Macula-centered field.
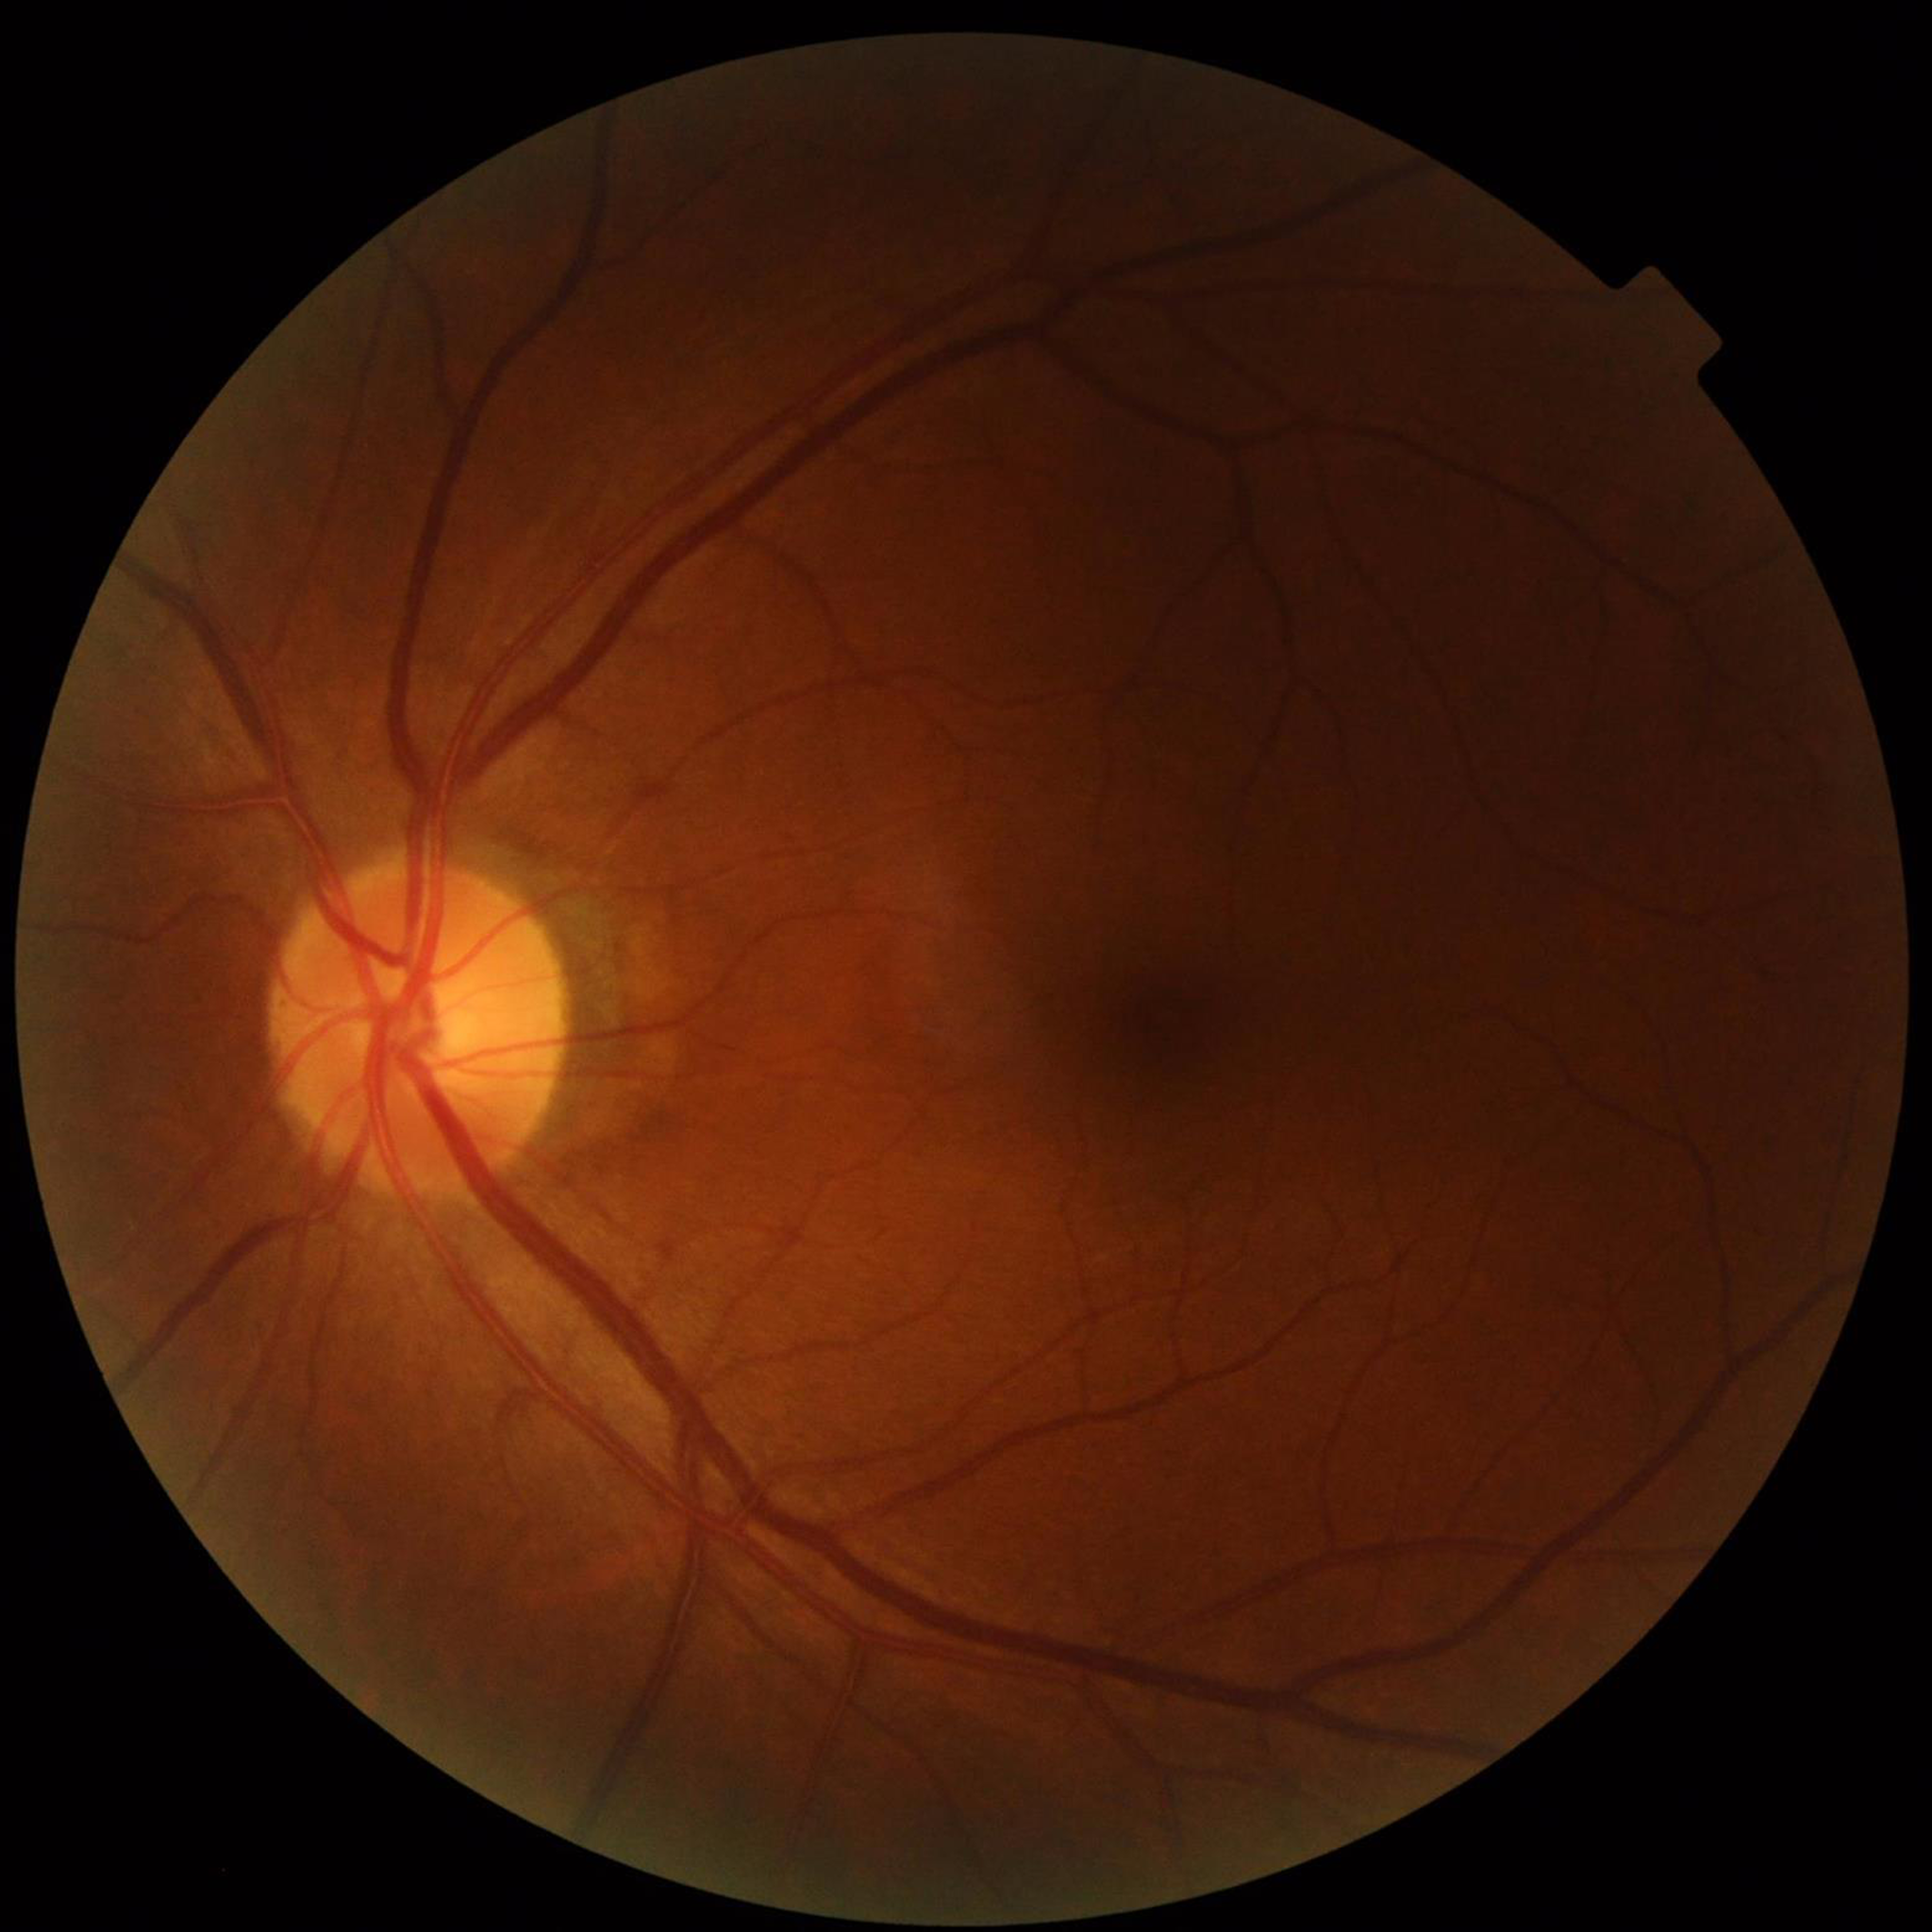
Quality assessment: no concerns identified.
Patient diagnosed with DR.